1240x1240. Wide-field contact fundus photograph of an infant:
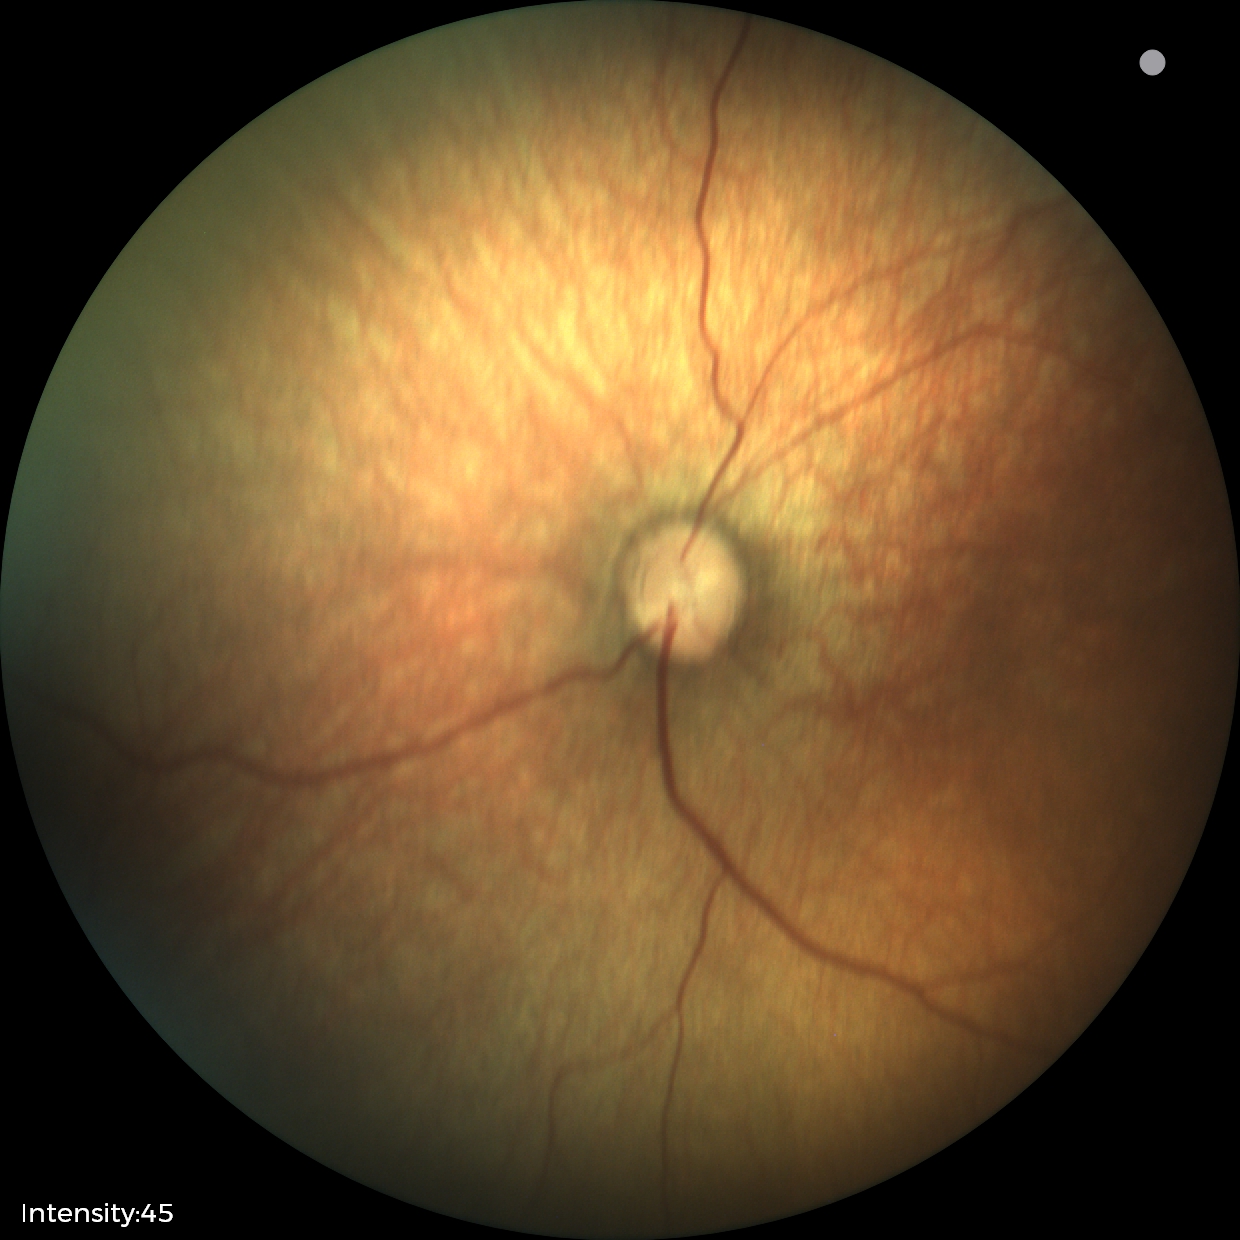

Screening: normal retinal appearance.